Macula-centered field · 1932 by 1932 pixels — 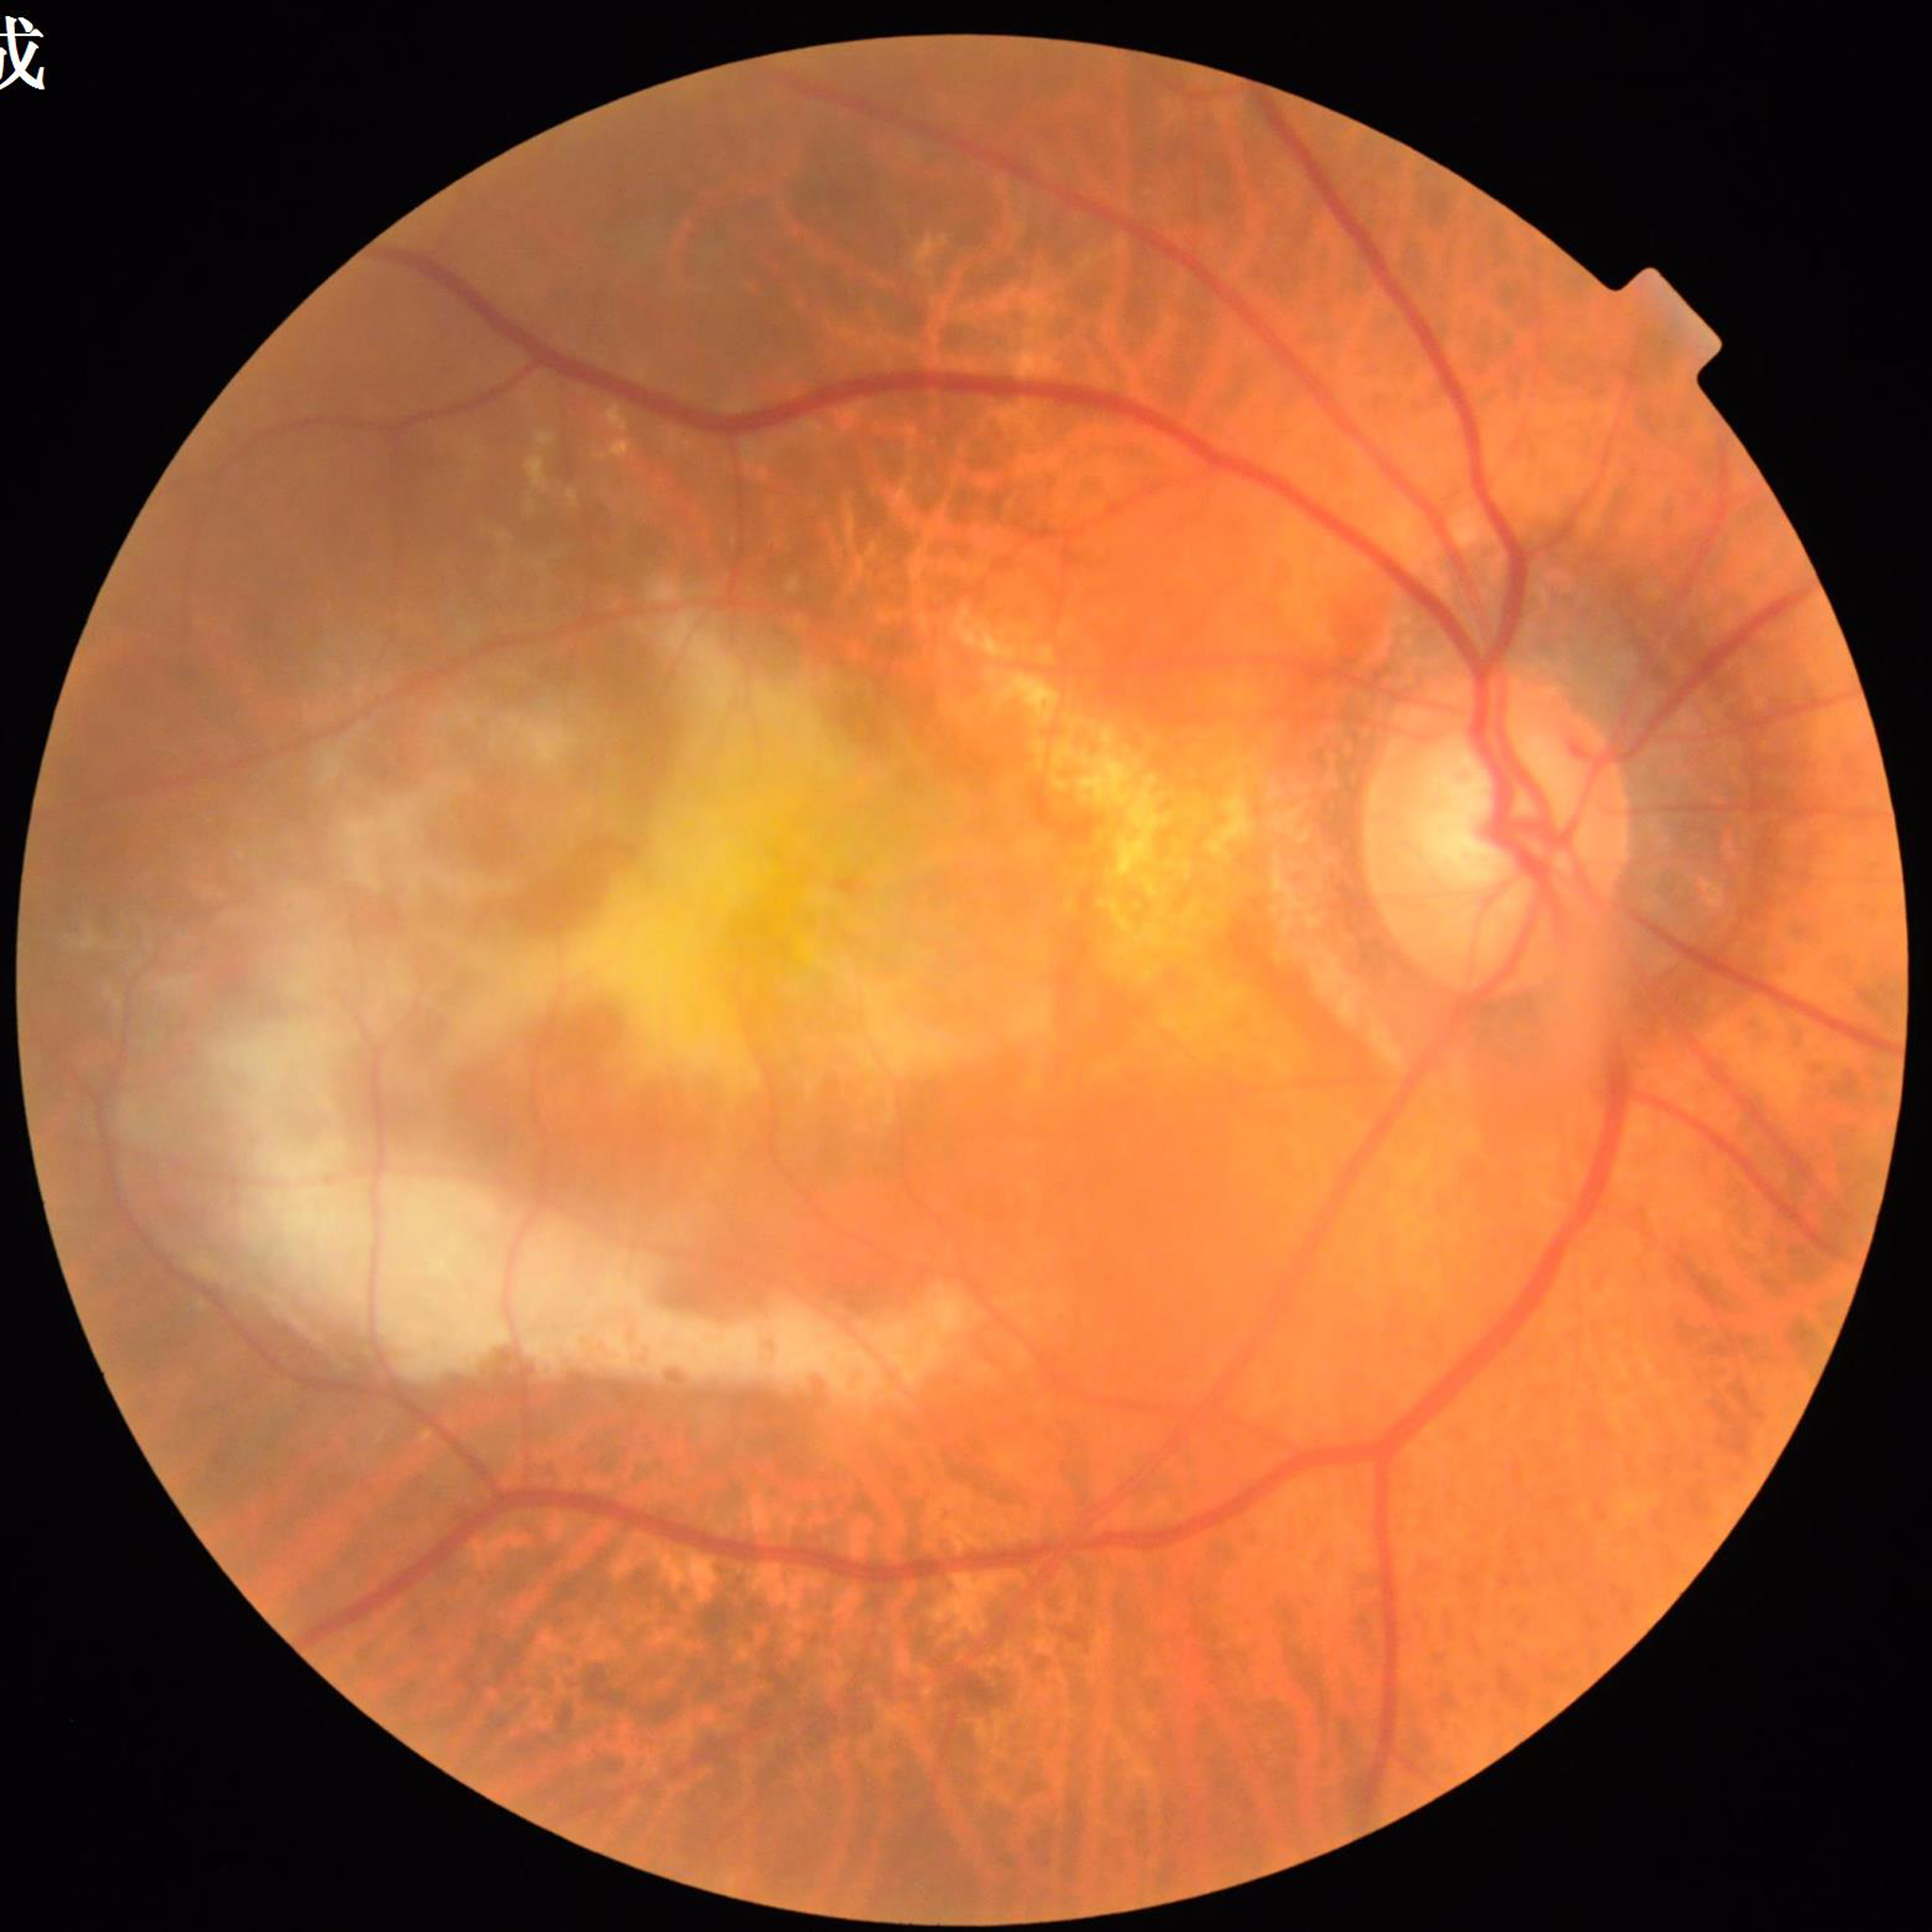

Color fundus photo. Patient diagnosed with age-related macular degeneration.
Photo quality: adequate.